848 by 848 pixels · modified Davis classification:
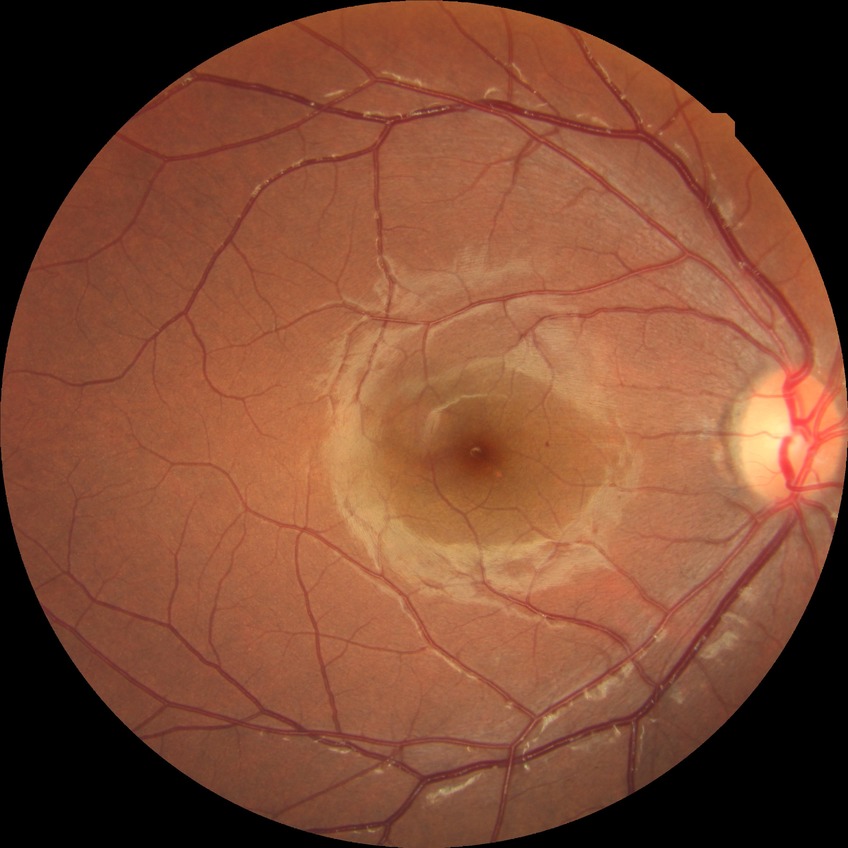 The retinopathy is classified as non-proliferative diabetic retinopathy. Diabetic retinopathy (DR) is simple diabetic retinopathy (SDR).